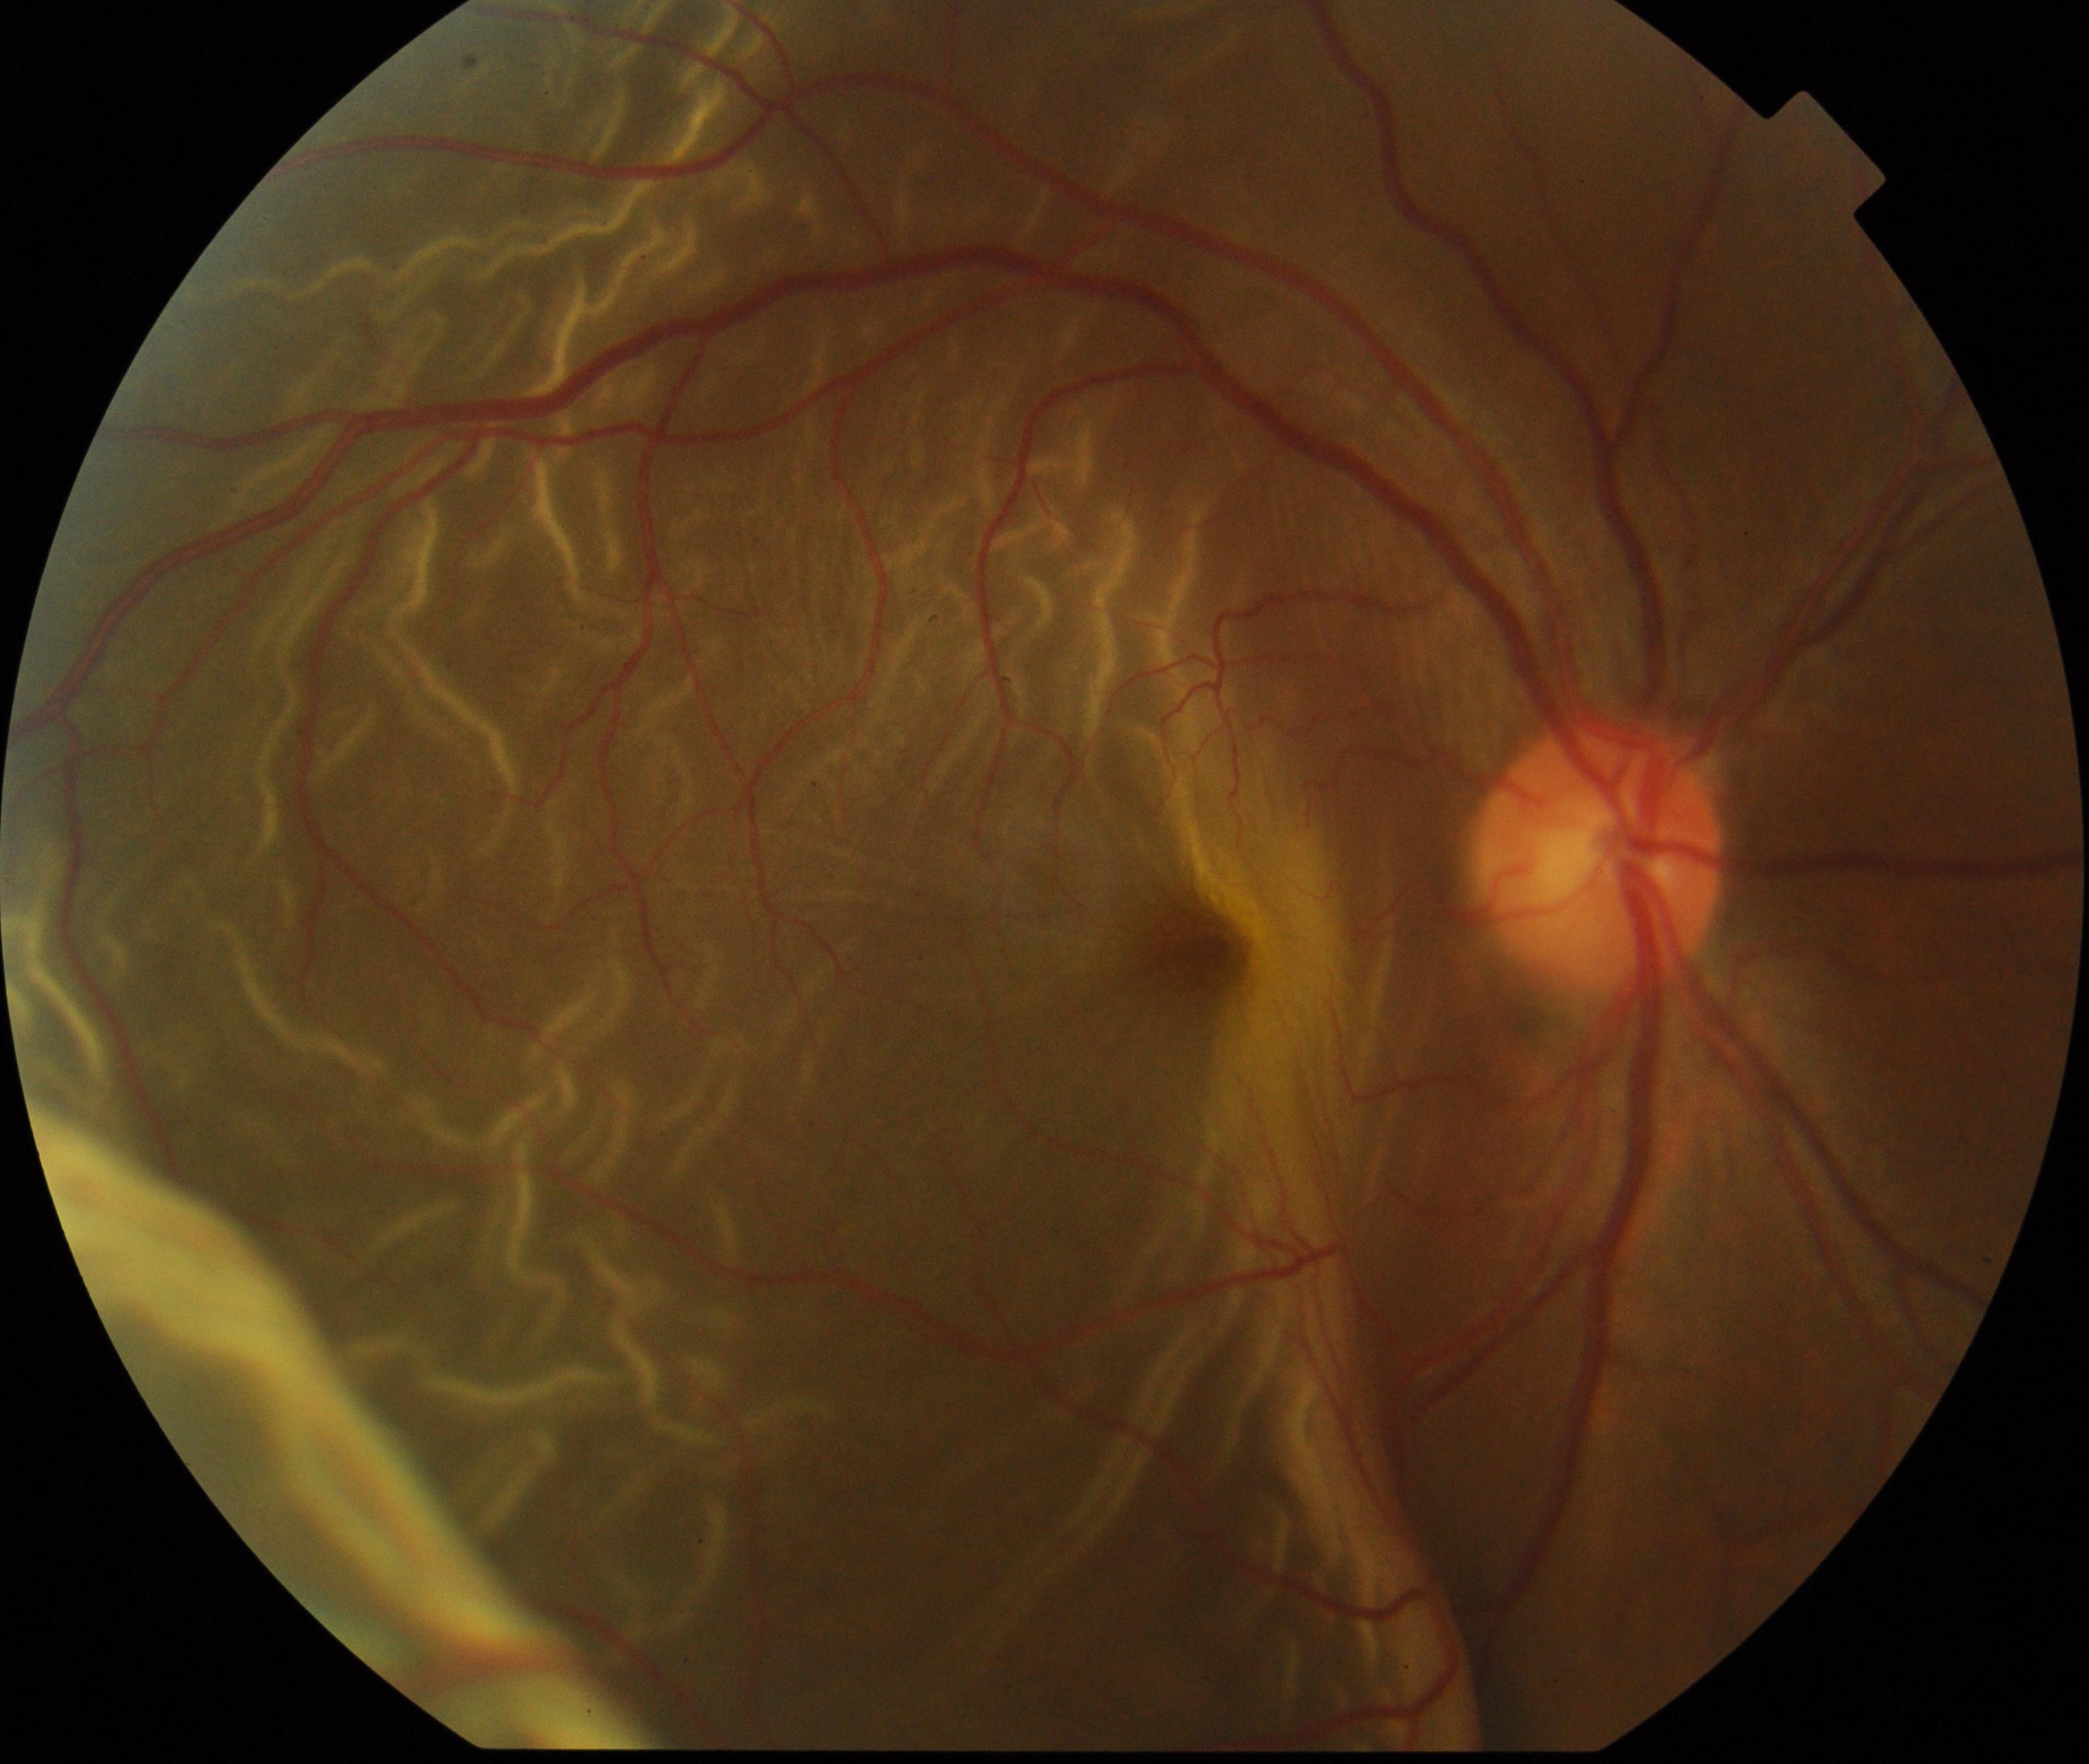
Demonstrates rhegmatogenous retinal detachment. Features include slightly opaque, convex or corrugated appearance of elevated retina, sometimes with retinal breaks in view.